2352 x 1568 pixels.
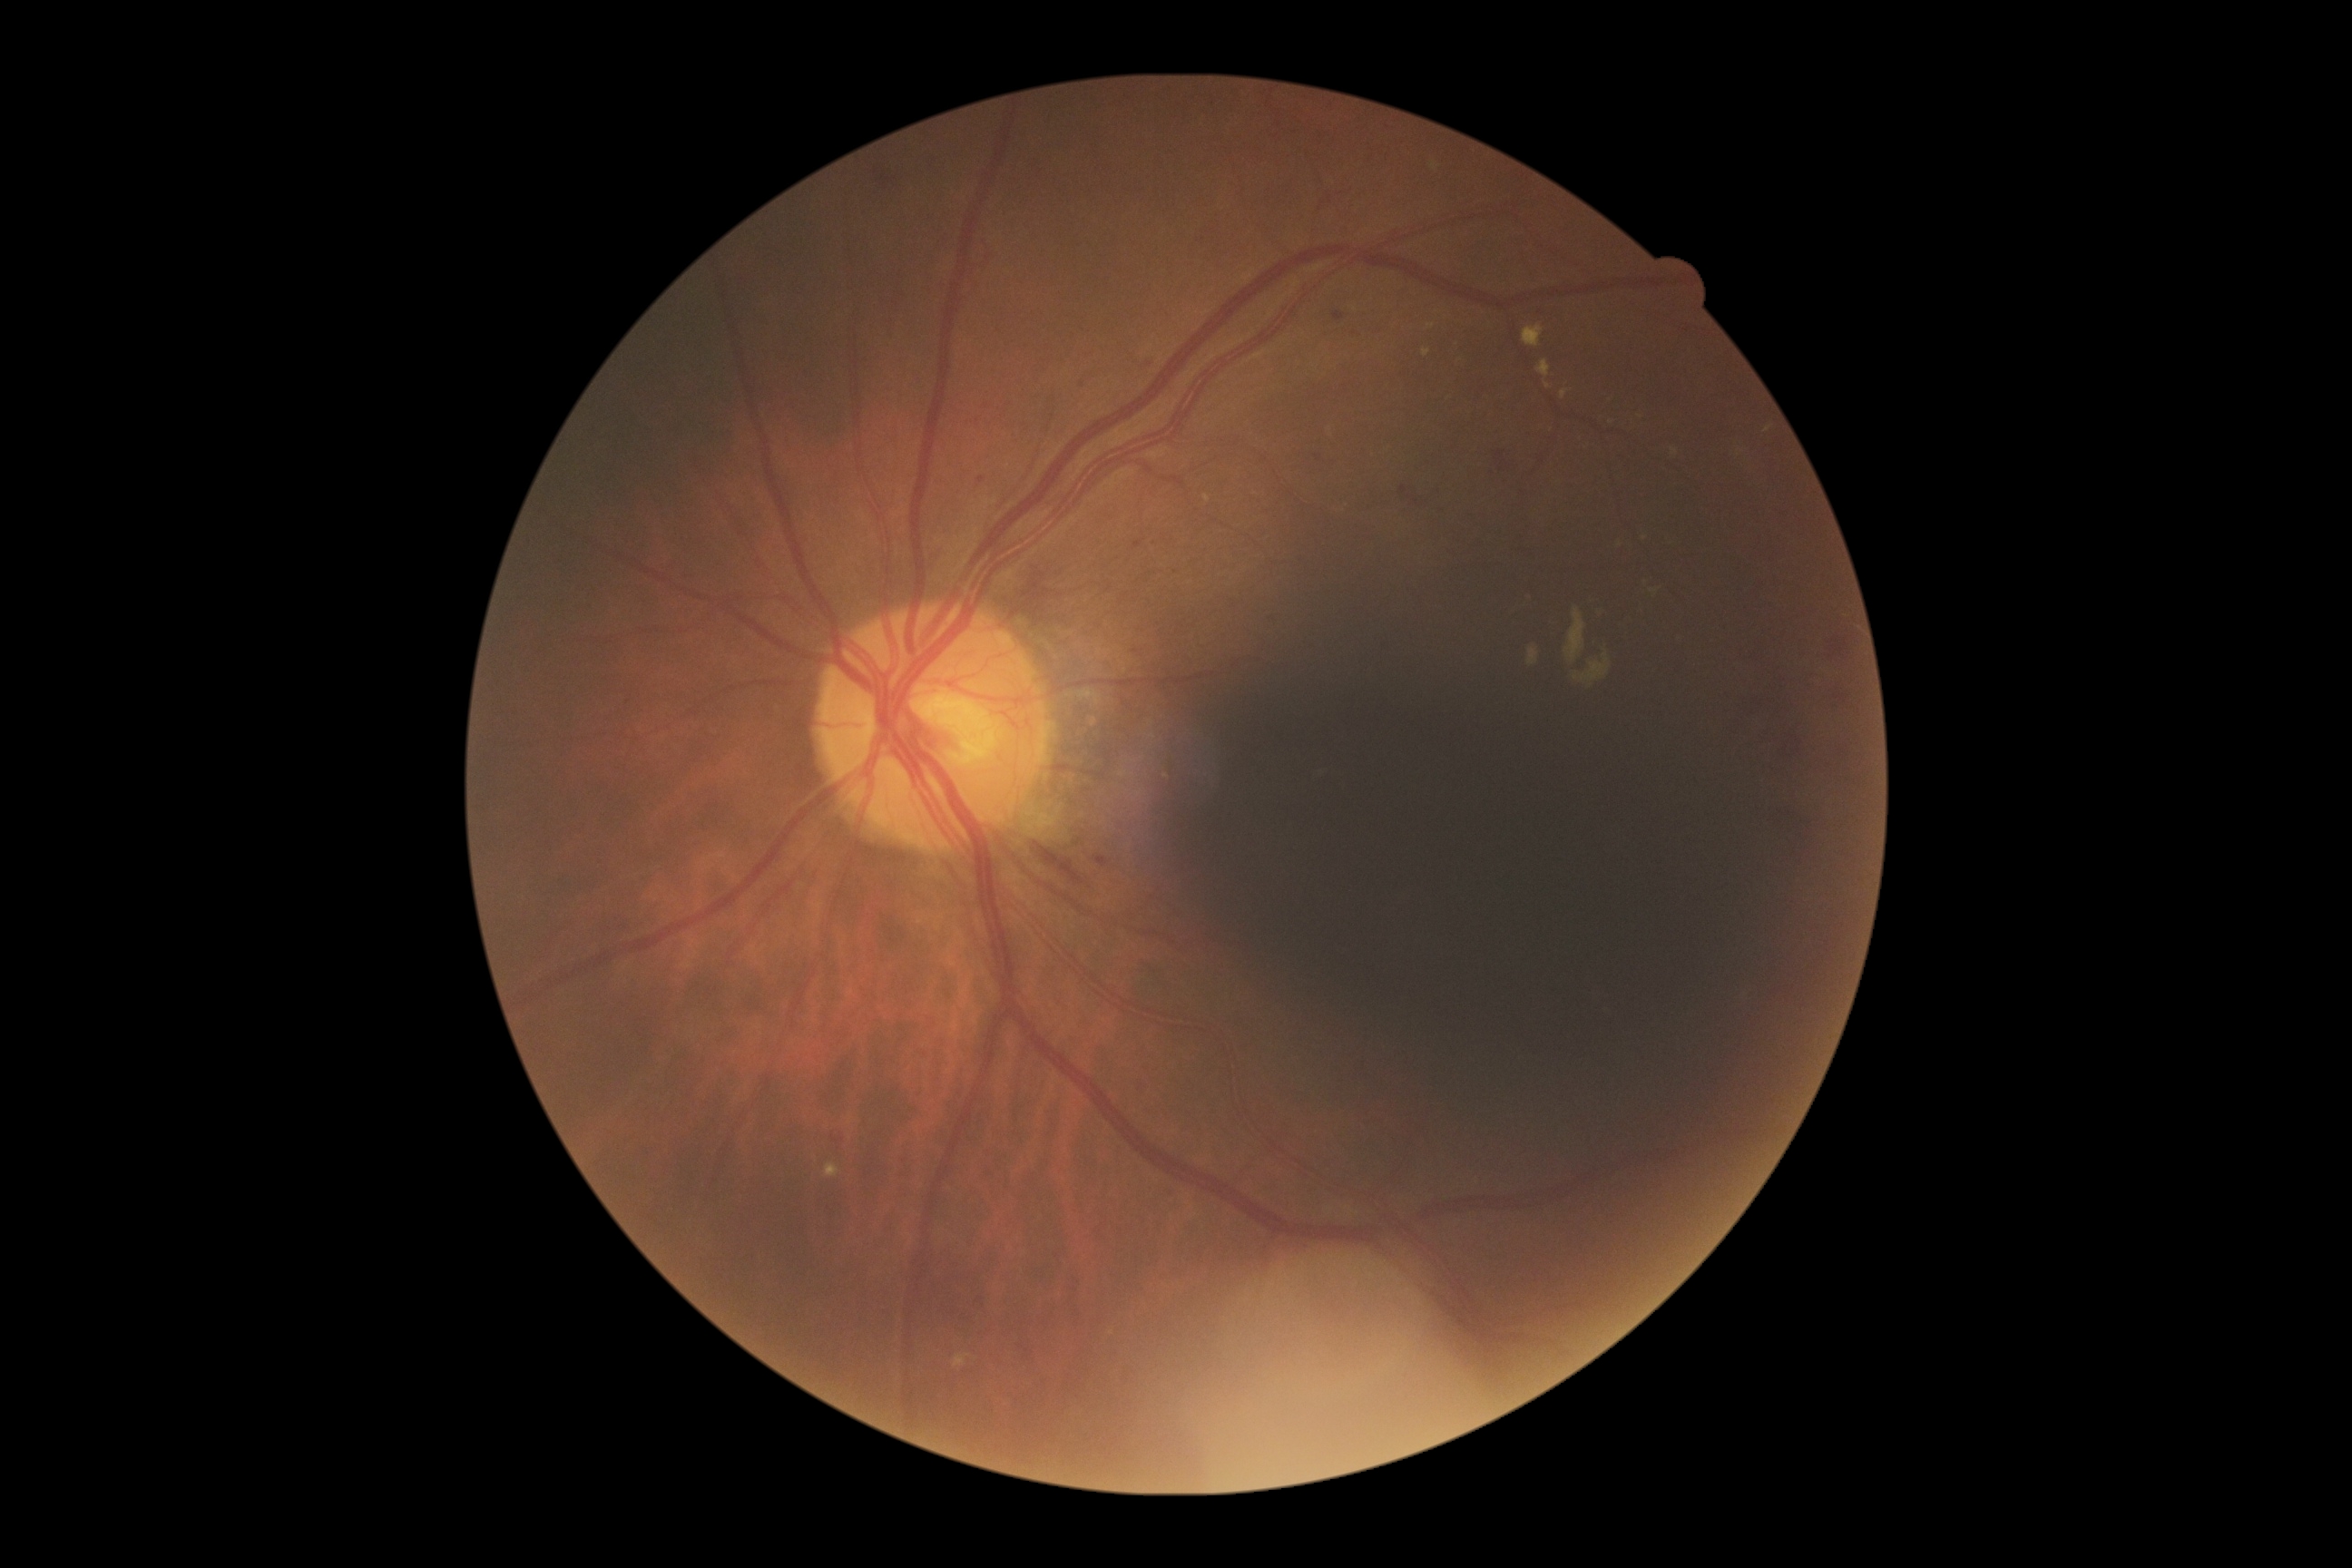 DR stage: grade 2. Disease class: non-proliferative diabetic retinopathy.